Color fundus photograph, 45-degree field of view, 1380x1382:
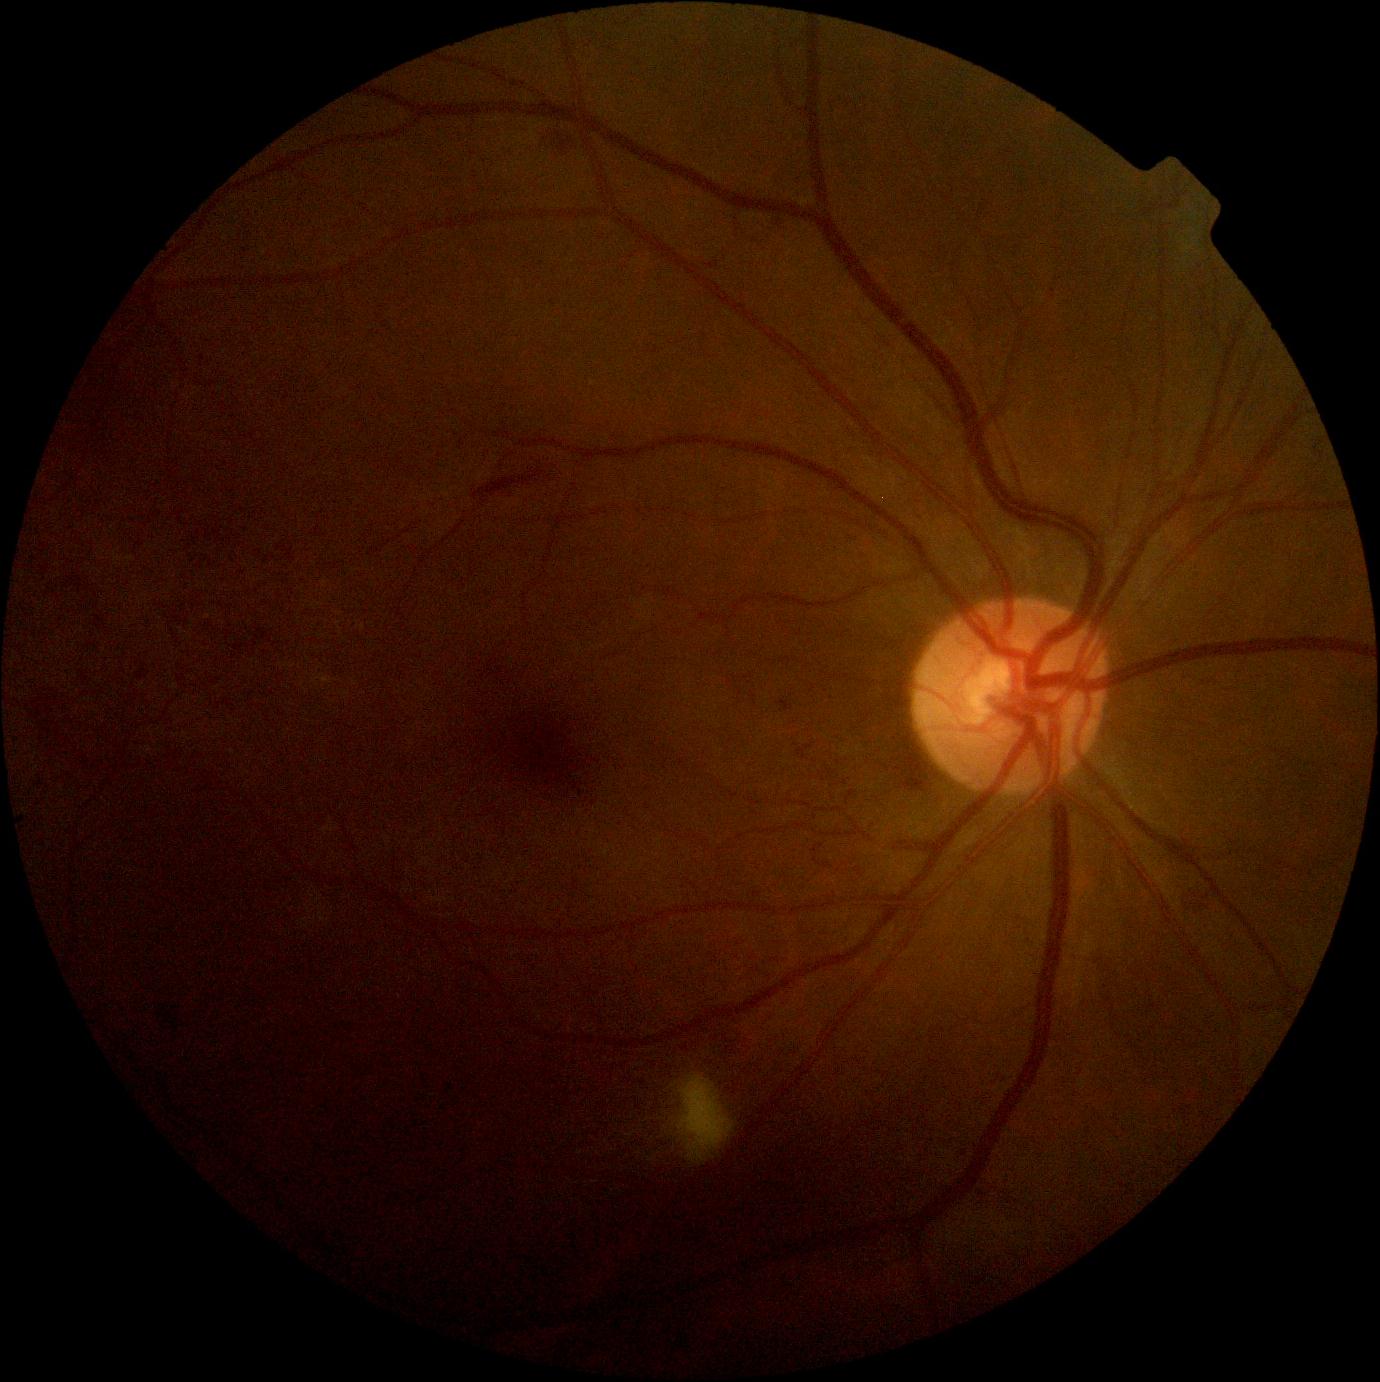
diabetic retinopathy (DR): 2/4.